45-degree field of view. Fundus photo
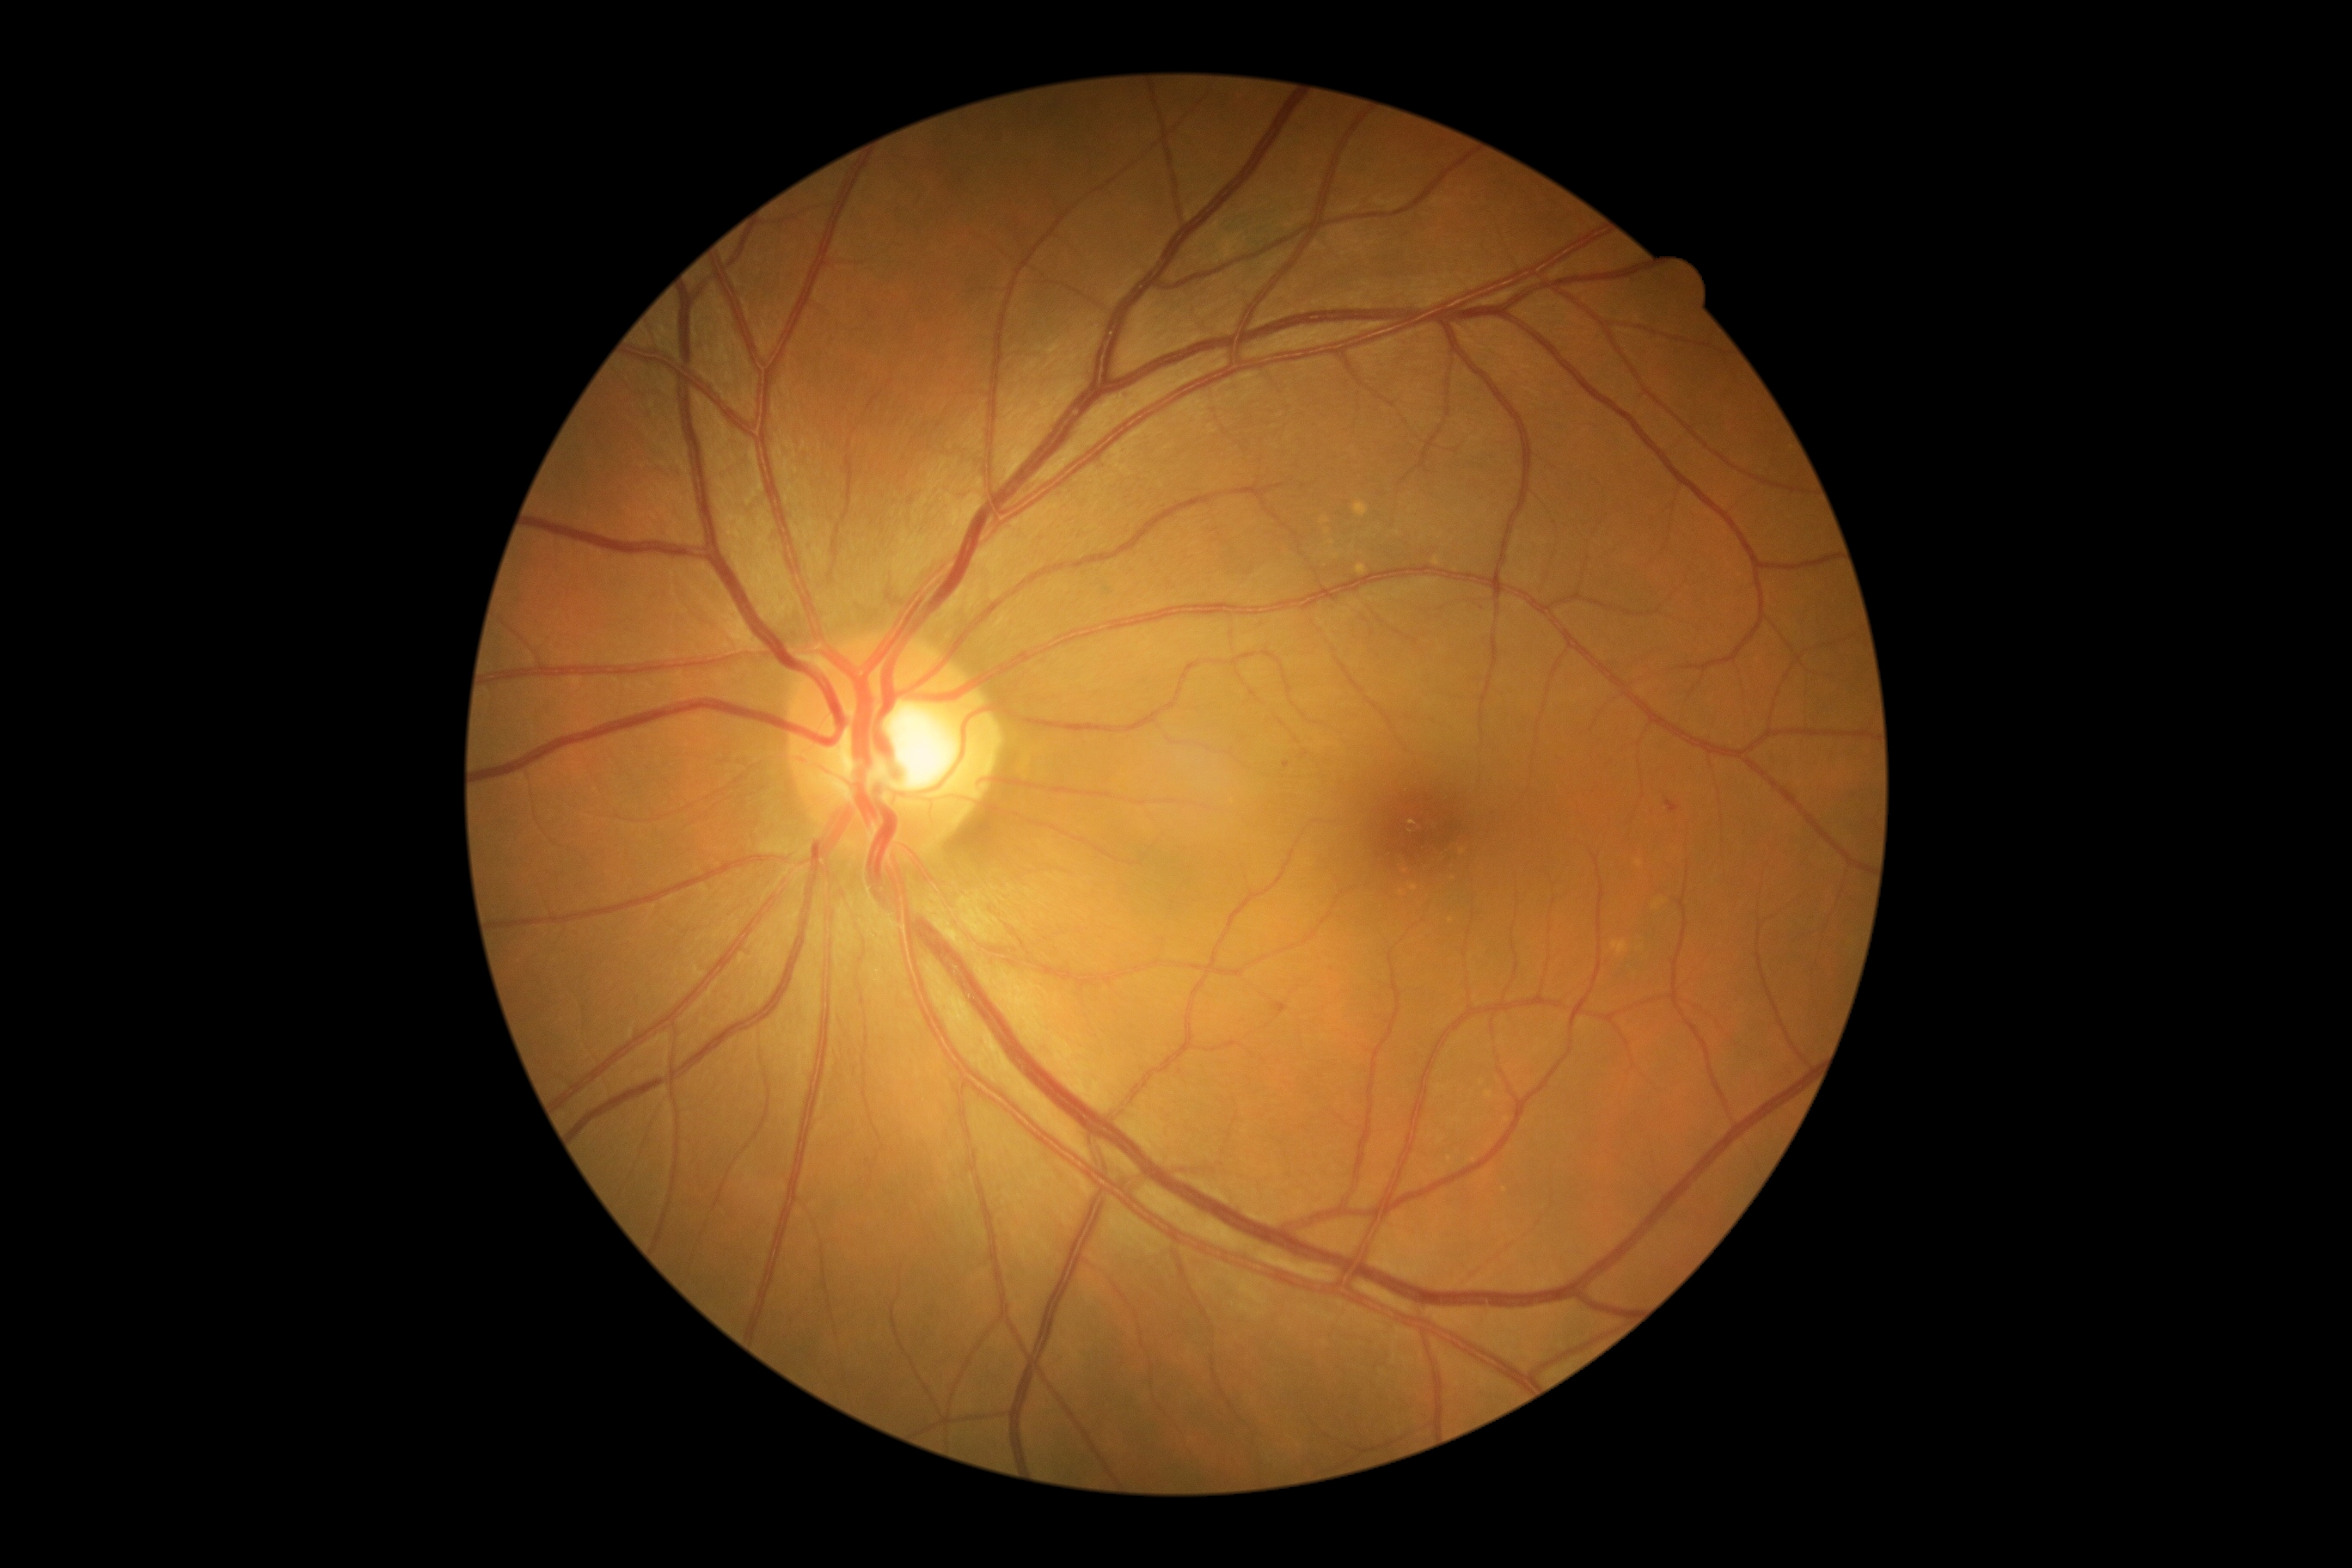 Retinopathy grade is 1/4; non-proliferative diabetic retinopathy
hemorrhages: absent
hard exudates: absent
soft exudates: absent
microaneurysms: rect(1667, 800, 1674, 809)
Small microaneurysms approximately at 1286:766